ONH-centered crop from a color fundus image: 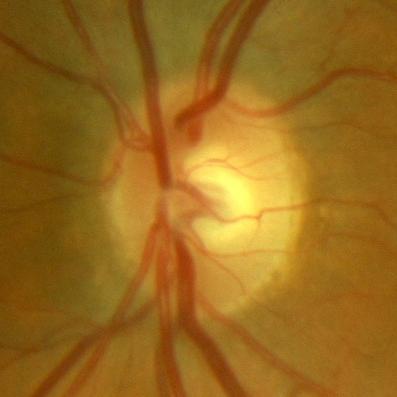
Finding: no glaucomatous findings.